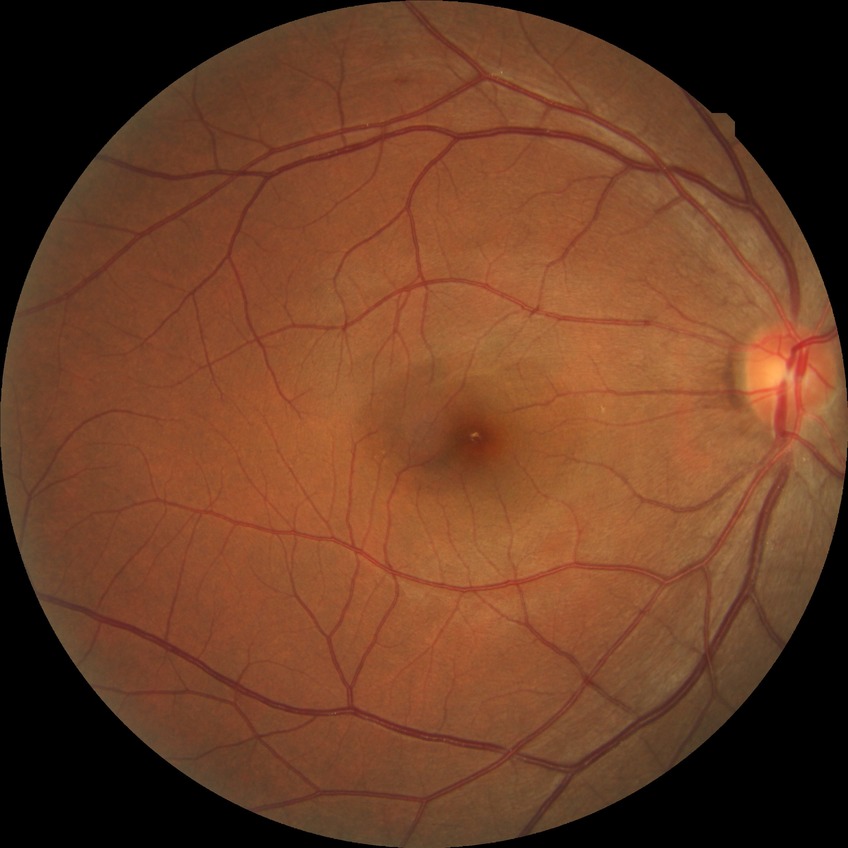 Diabetic retinopathy (DR) is NDR (no diabetic retinopathy).